240 by 240 pixels, camera: Nidek AFC-330, non-mydriatic — 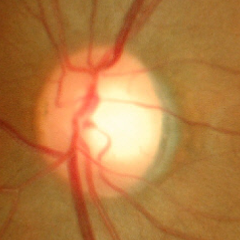
No glaucoma.